1440 by 1080 pixels. RetCam wide-field infant fundus image.
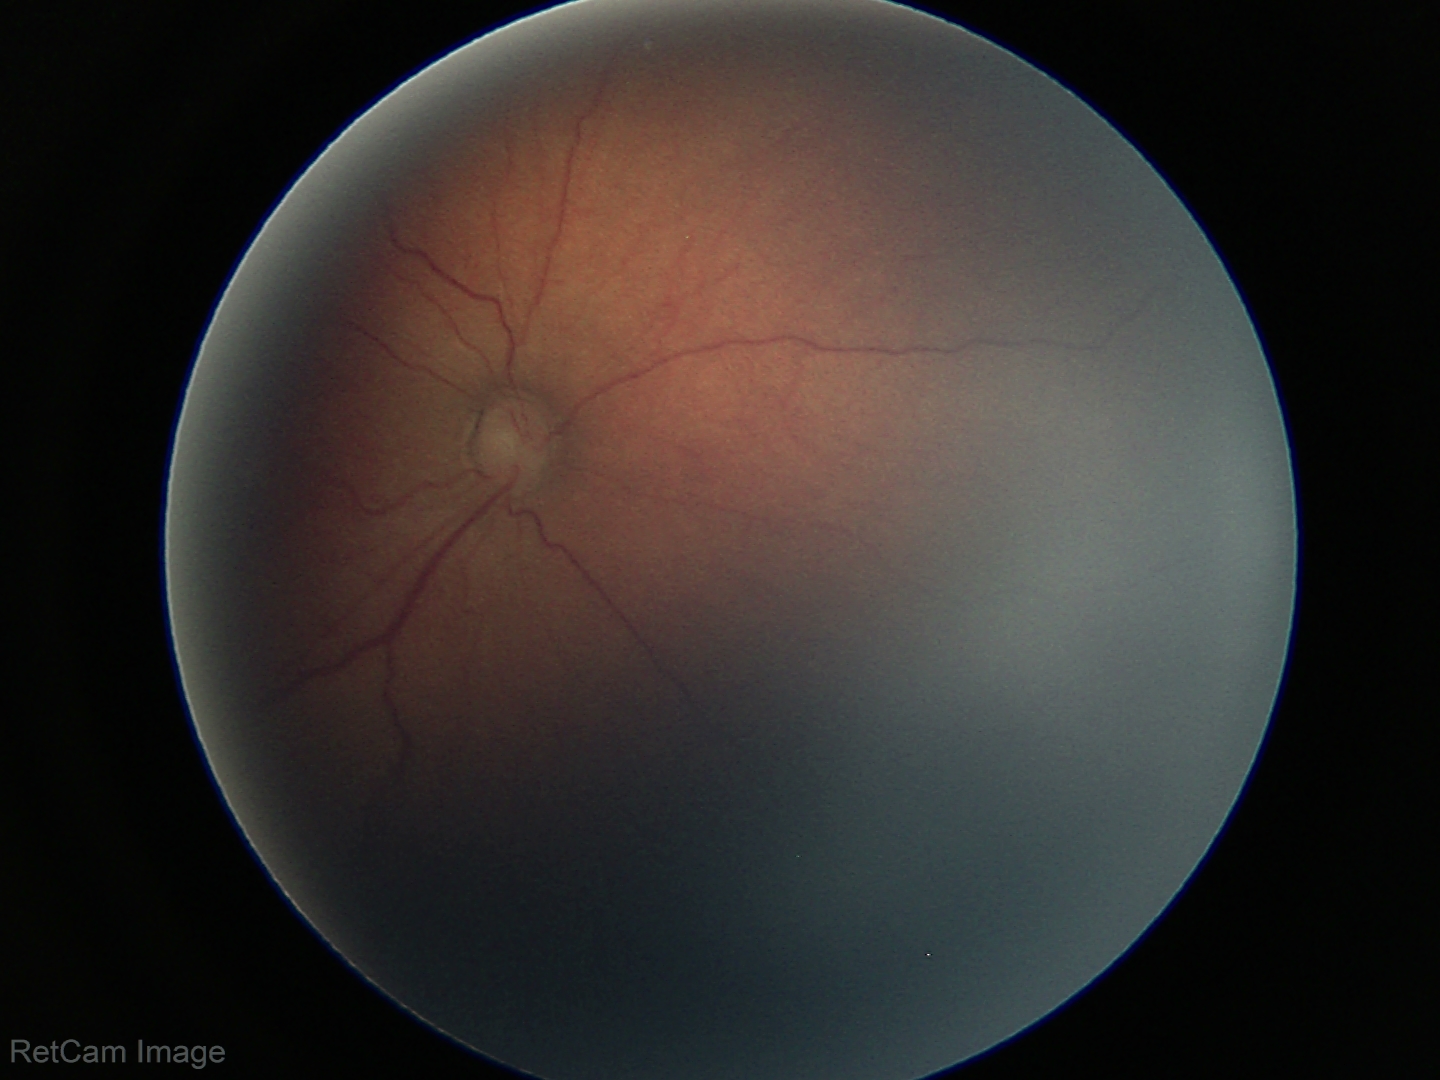

Q: What was the screening finding?
A: retinopathy of prematurity stage 3 — ridge with extraretinal fibrovascular proliferation
Q: Is plus disease present?
A: no plus disease